848 by 848 pixels. Without pupil dilation — 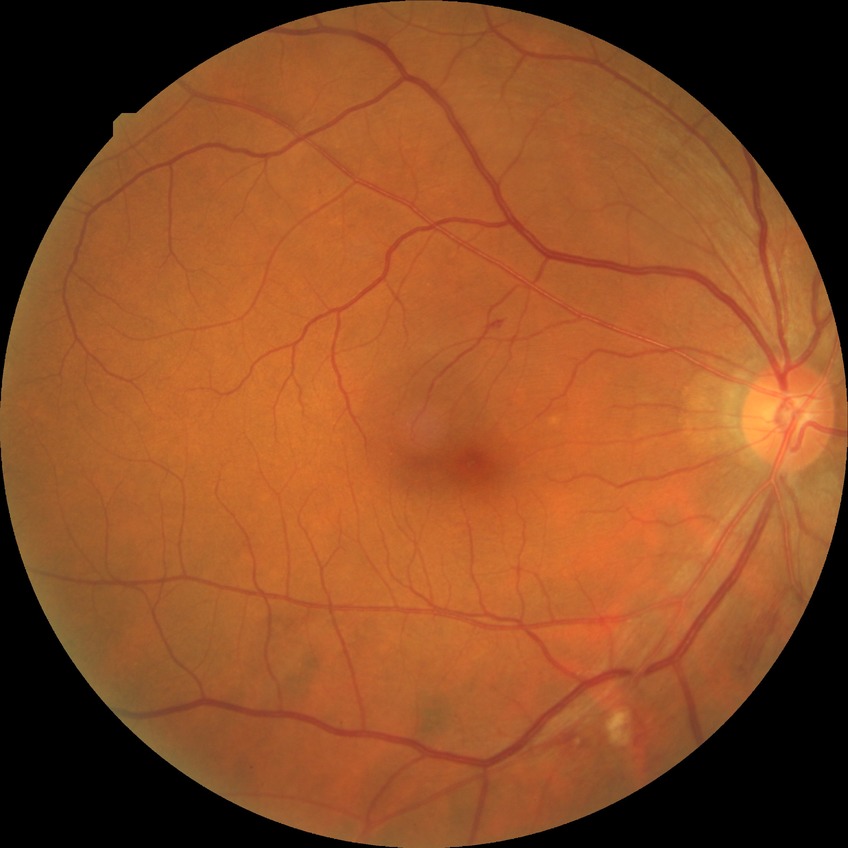 DR class@non-proliferative diabetic retinopathy, diabetic retinopathy severity@pre-proliferative diabetic retinopathy.